Wide-field fundus photograph of an infant — 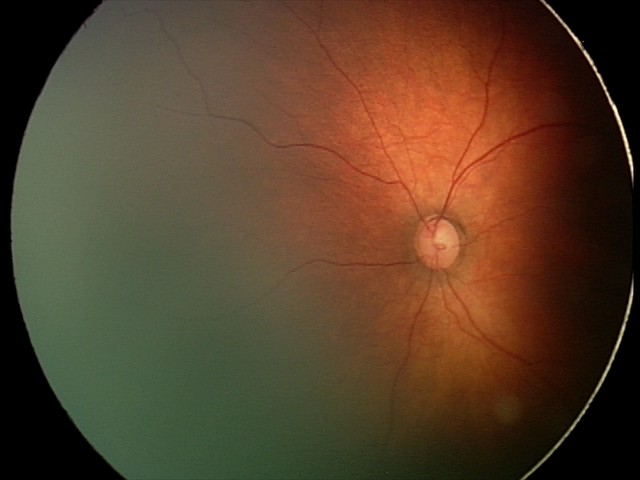

Q: What is the screening diagnosis?
A: no abnormal retinal findings